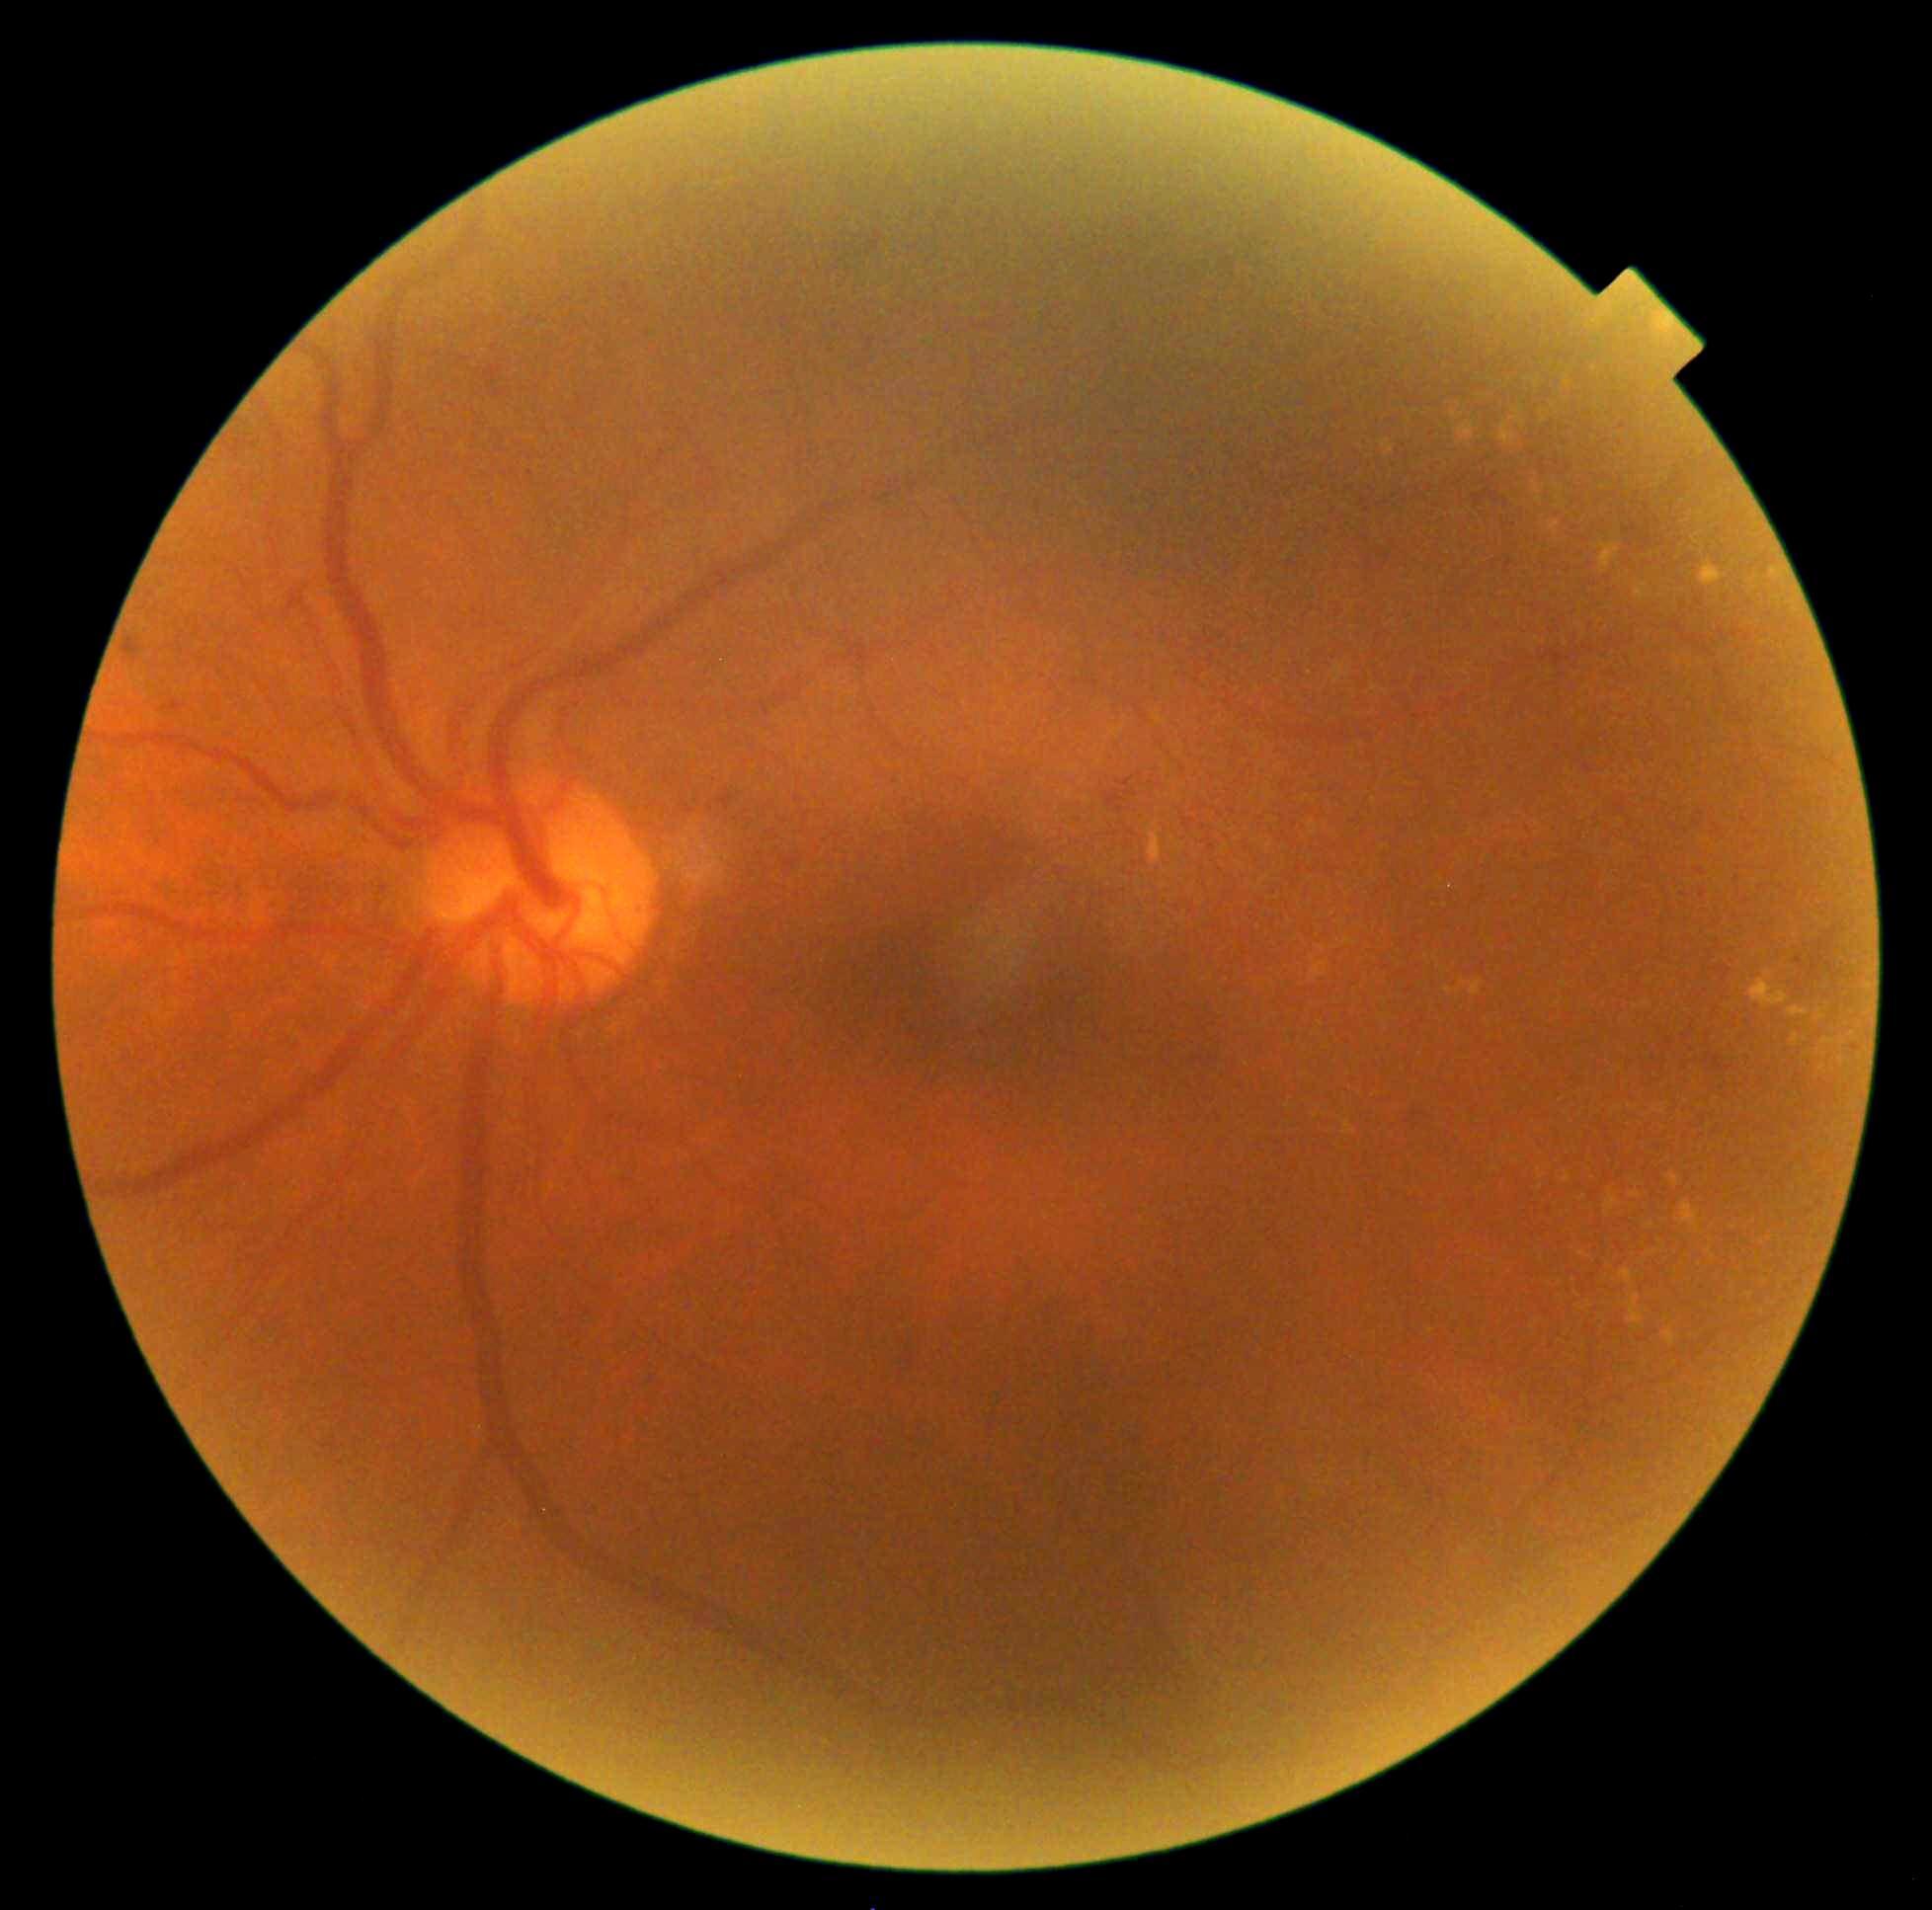
Diabetic retinopathy (DR): 2/4
Representative lesions:
hard exudates (EXs) (more not shown): box(1793, 1034, 1800, 1044); box(1621, 1269, 1634, 1287); box(1822, 1039, 1833, 1044); box(1678, 1202, 1700, 1232); box(1549, 520, 1560, 535); box(1537, 1169, 1544, 1180); box(1379, 440, 1396, 456); box(1650, 1250, 1658, 1255); box(1456, 422, 1476, 441)
Additional small EXs near [1559,508]; [1537,384]; [1577,1295]; [1541,1188]; [1559,488]; [1750,1295]